1240 x 1240 pixels · wide-field fundus photograph of an infant:
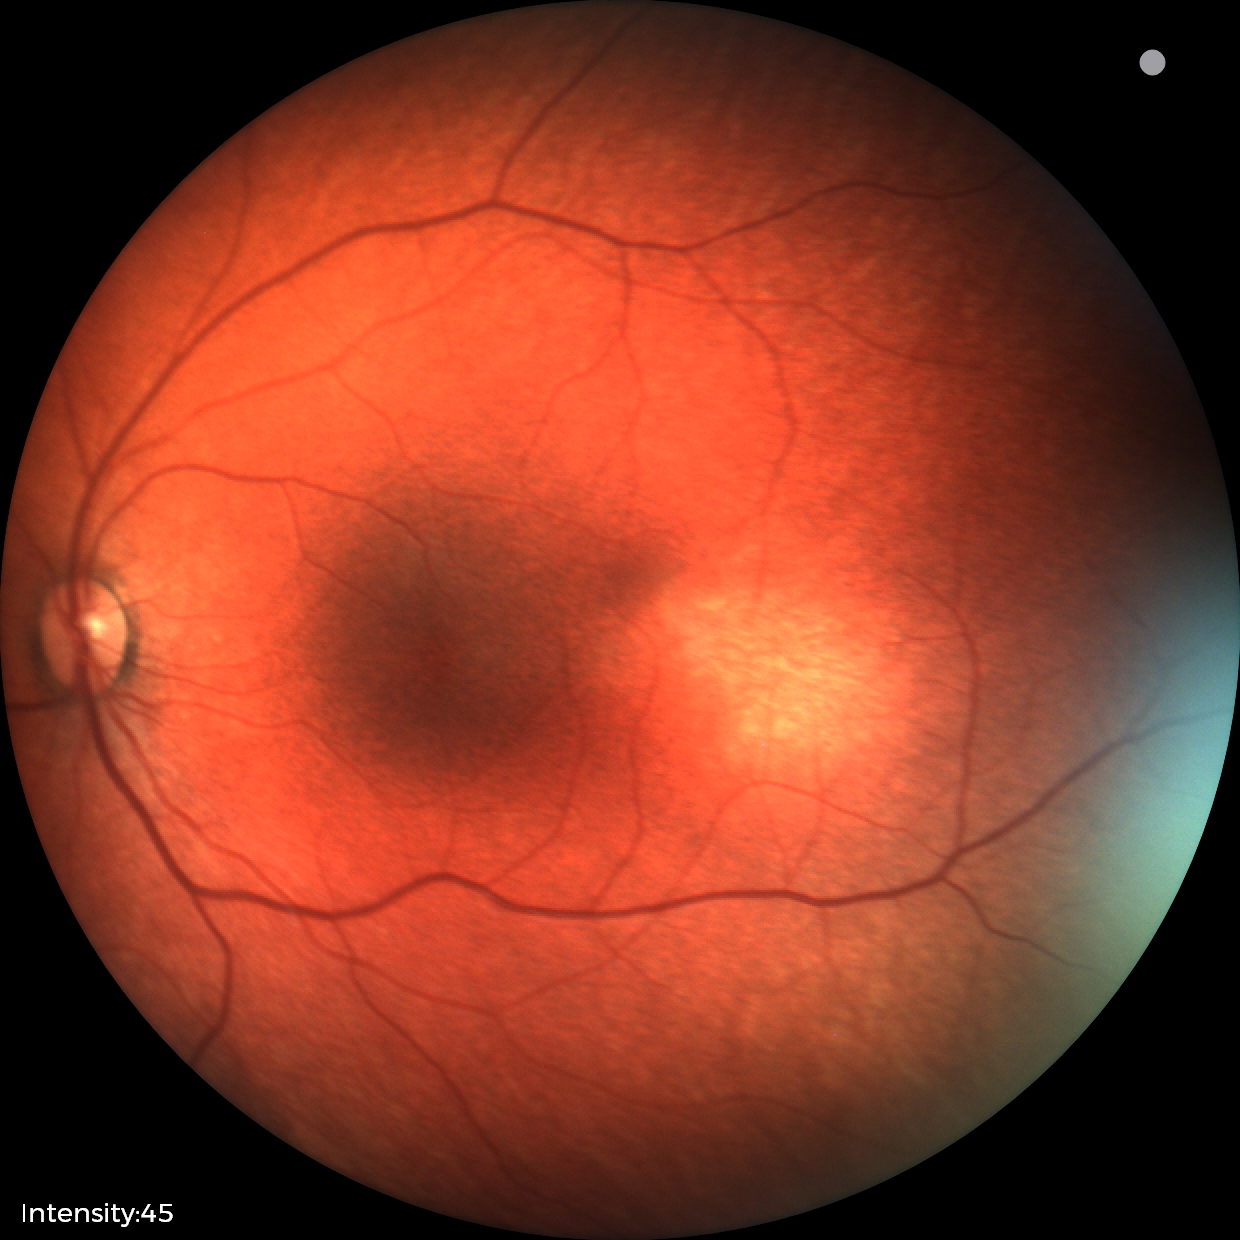
Assessment: normal fundus examination.